848x848px: 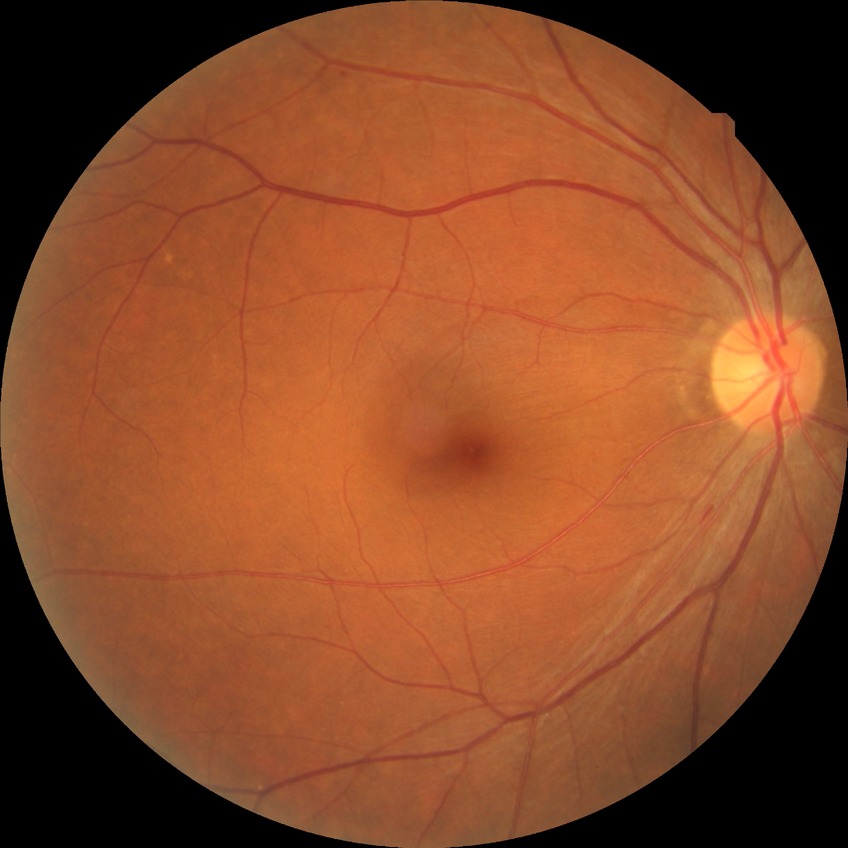 DR class=non-proliferative diabetic retinopathy, diabetic retinopathy (DR)=SDR (simple diabetic retinopathy).